Infant wide-field fundus photograph: 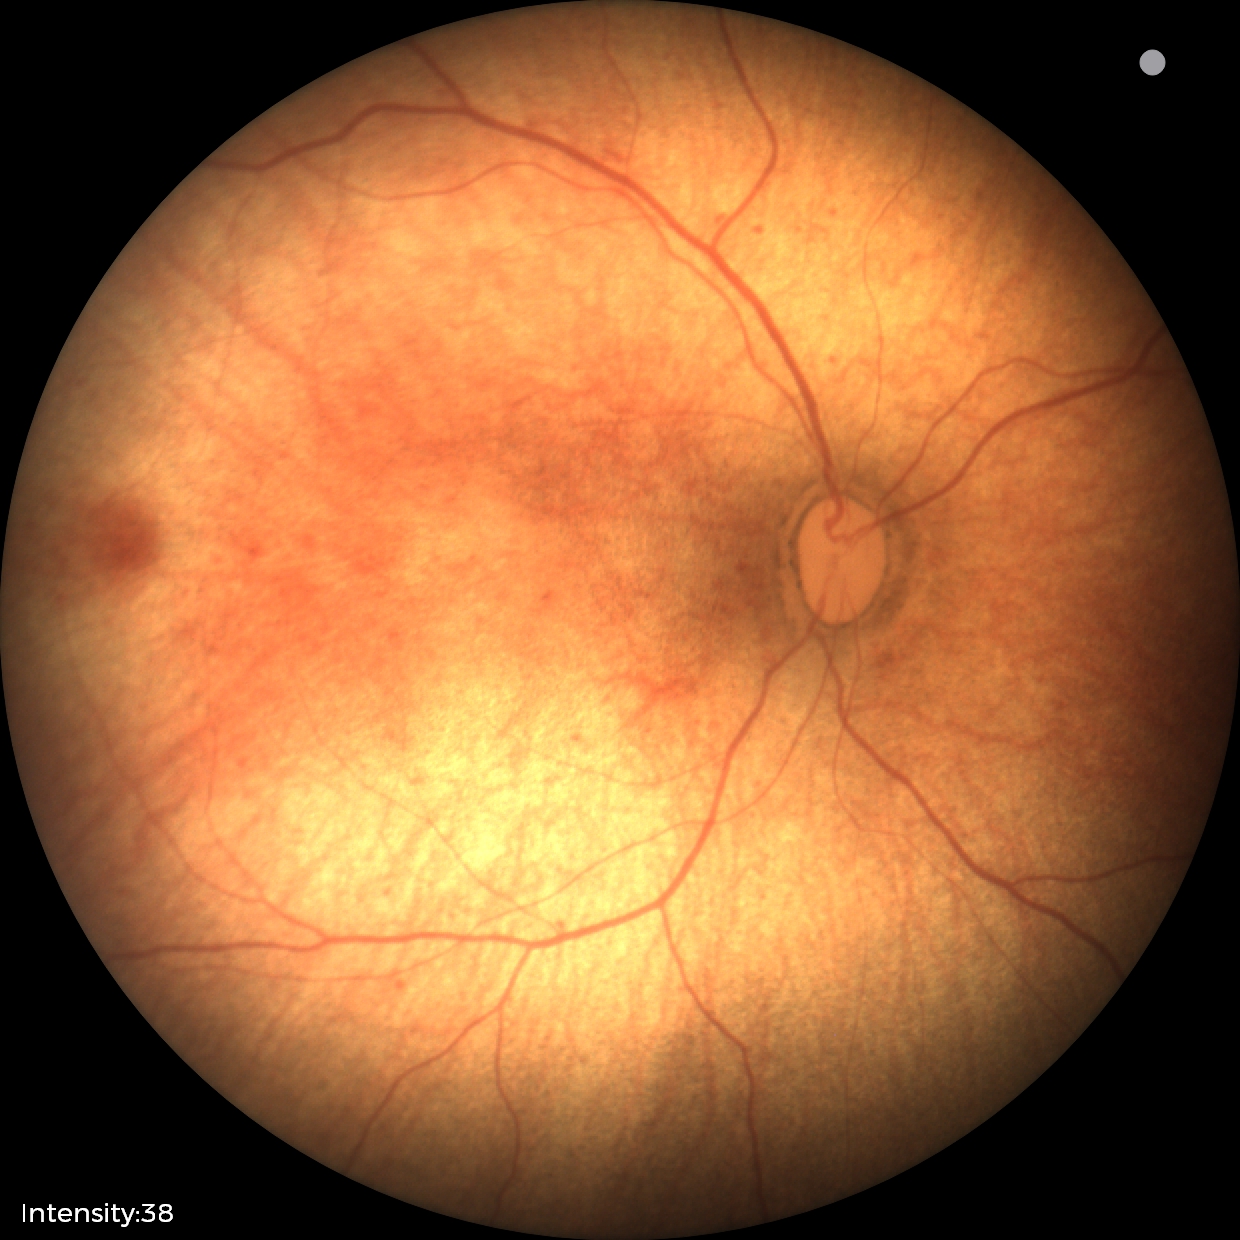 Q: What was the screening finding?
A: physiological retinal finding